Optic disc region of a color fundus photo: 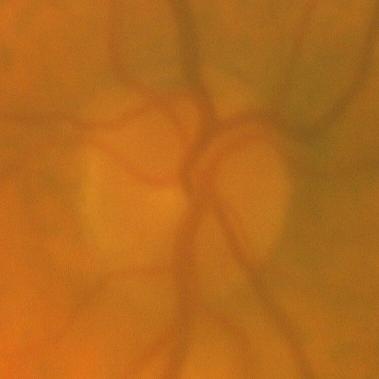

No glaucomatous findings.